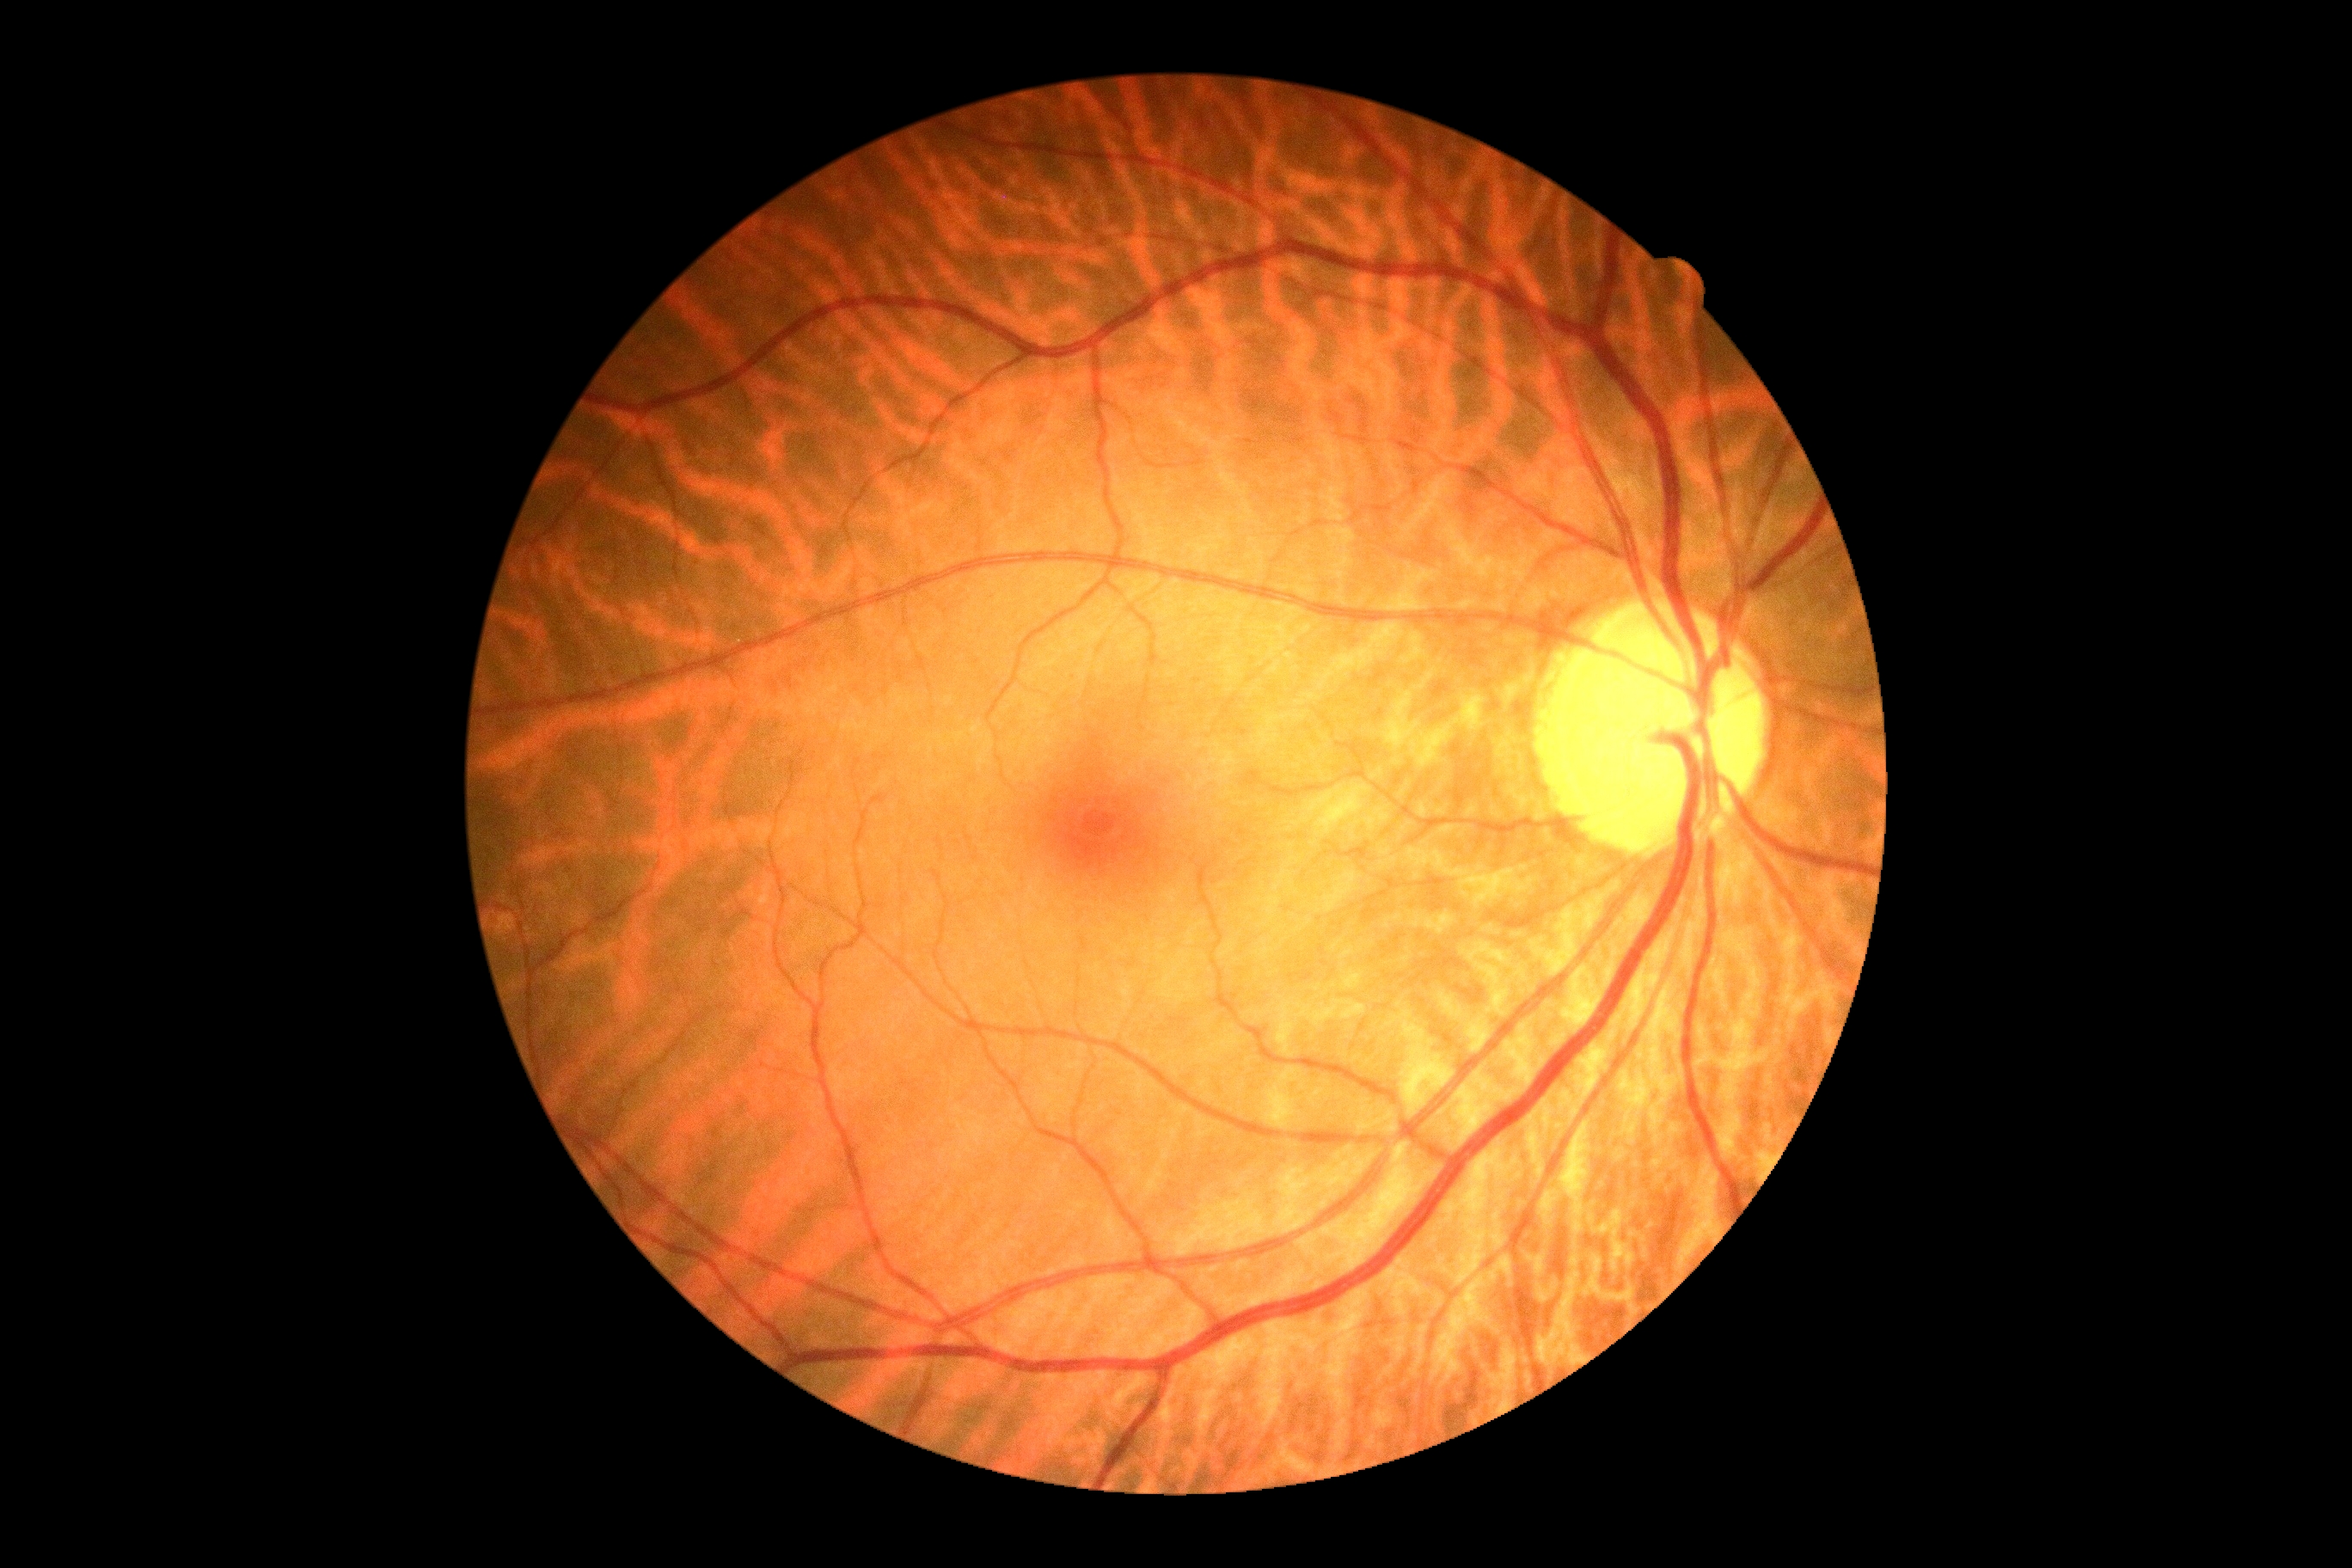 dr_impression: negative for DR
dr_grade: no apparent diabetic retinopathy (grade 0) — no visible signs of diabetic retinopathy